FOV: 45 degrees, NIDEK AFC-230 fundus camera
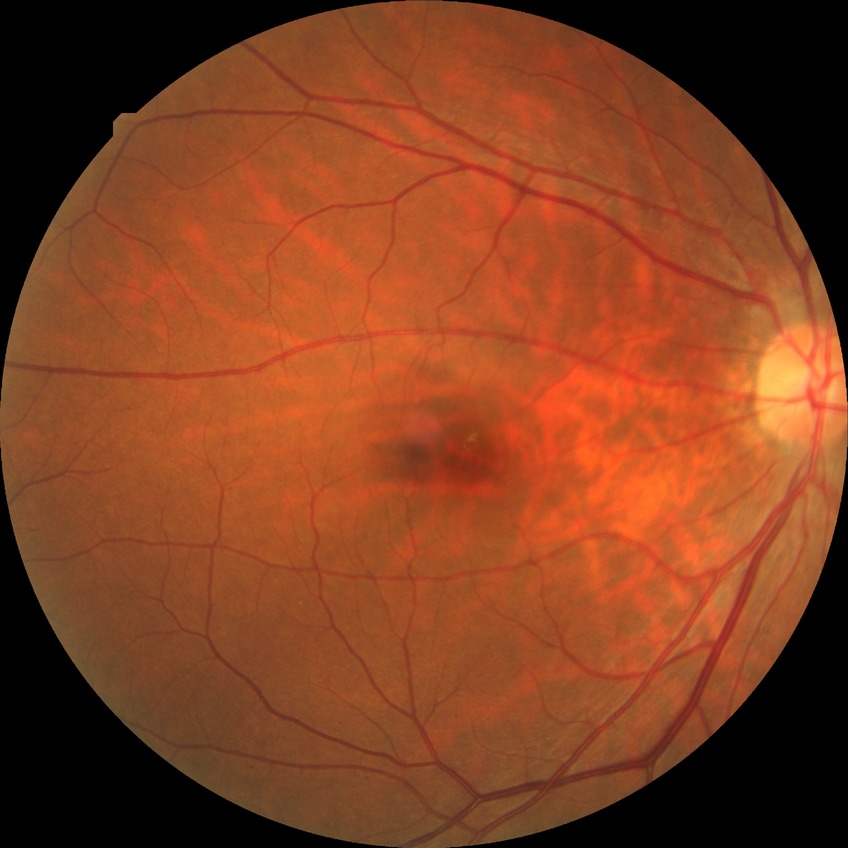 Diabetic retinopathy (DR) is NDR (no diabetic retinopathy).